Retinal fundus photograph:
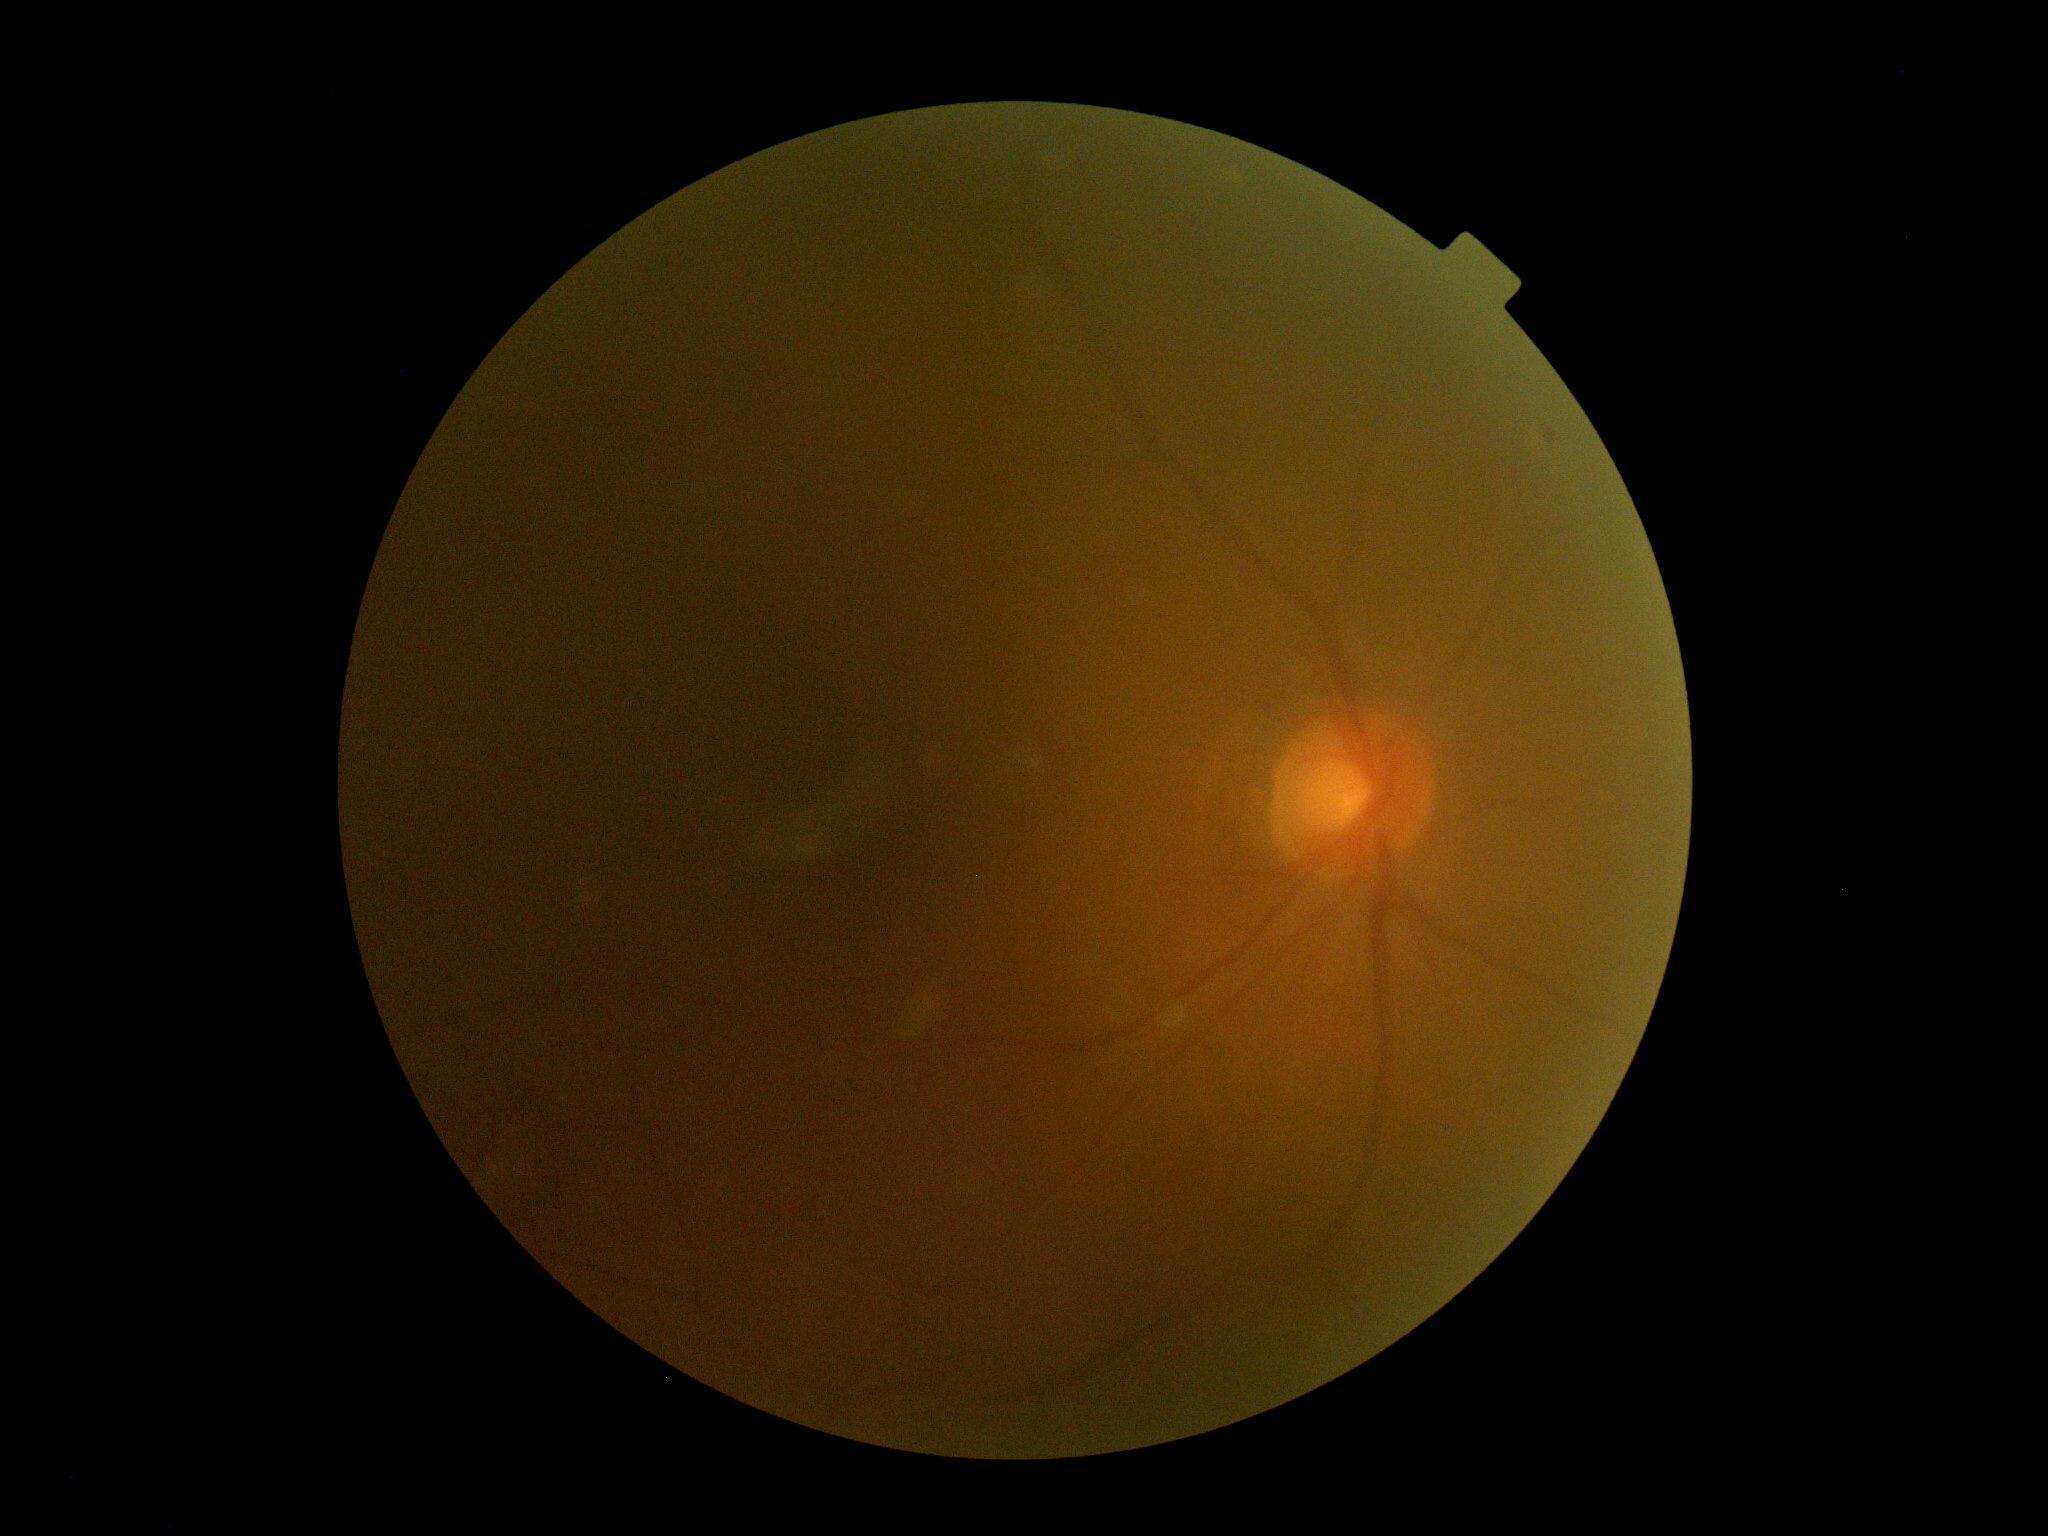 • DR grade: ungradable due to poor image quality
• image quality: insufficient